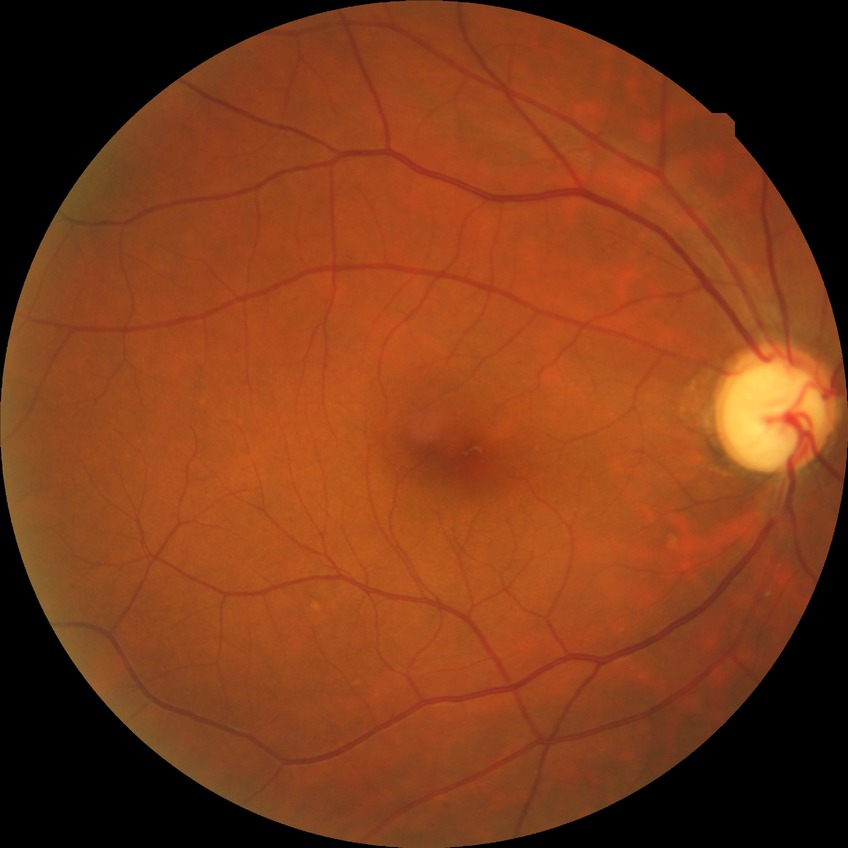
Retinopathy stage: no diabetic retinopathy.